Posterior pole color fundus photograph, modified Davis classification, 45-degree field of view, 848 by 848 pixels:
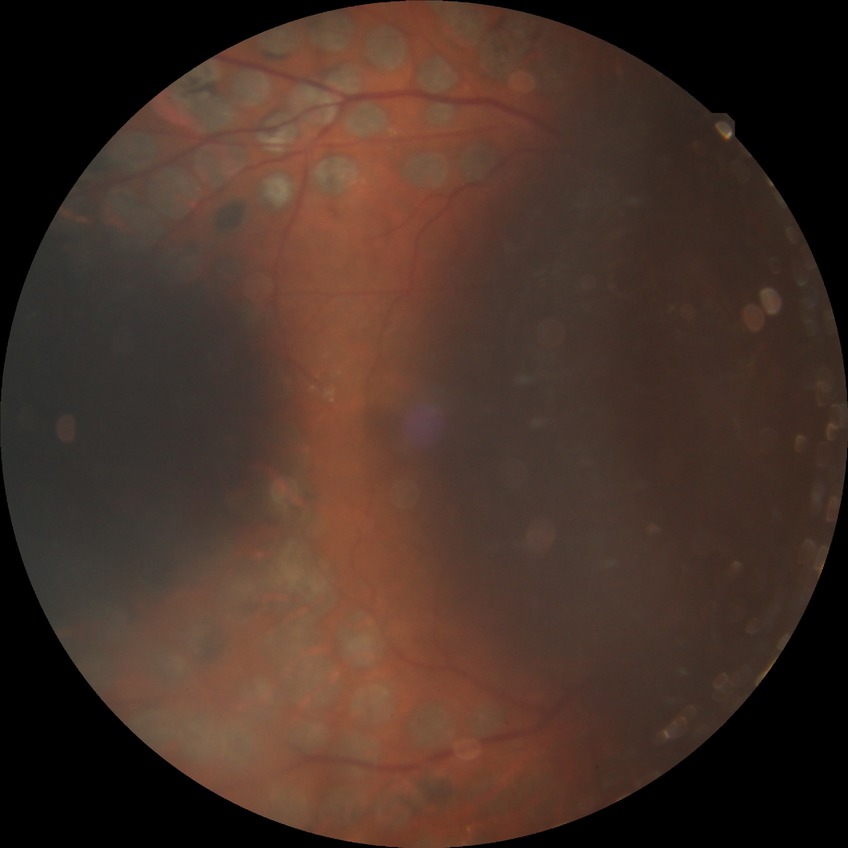

Diabetic retinopathy (DR) is PDR (proliferative diabetic retinopathy).